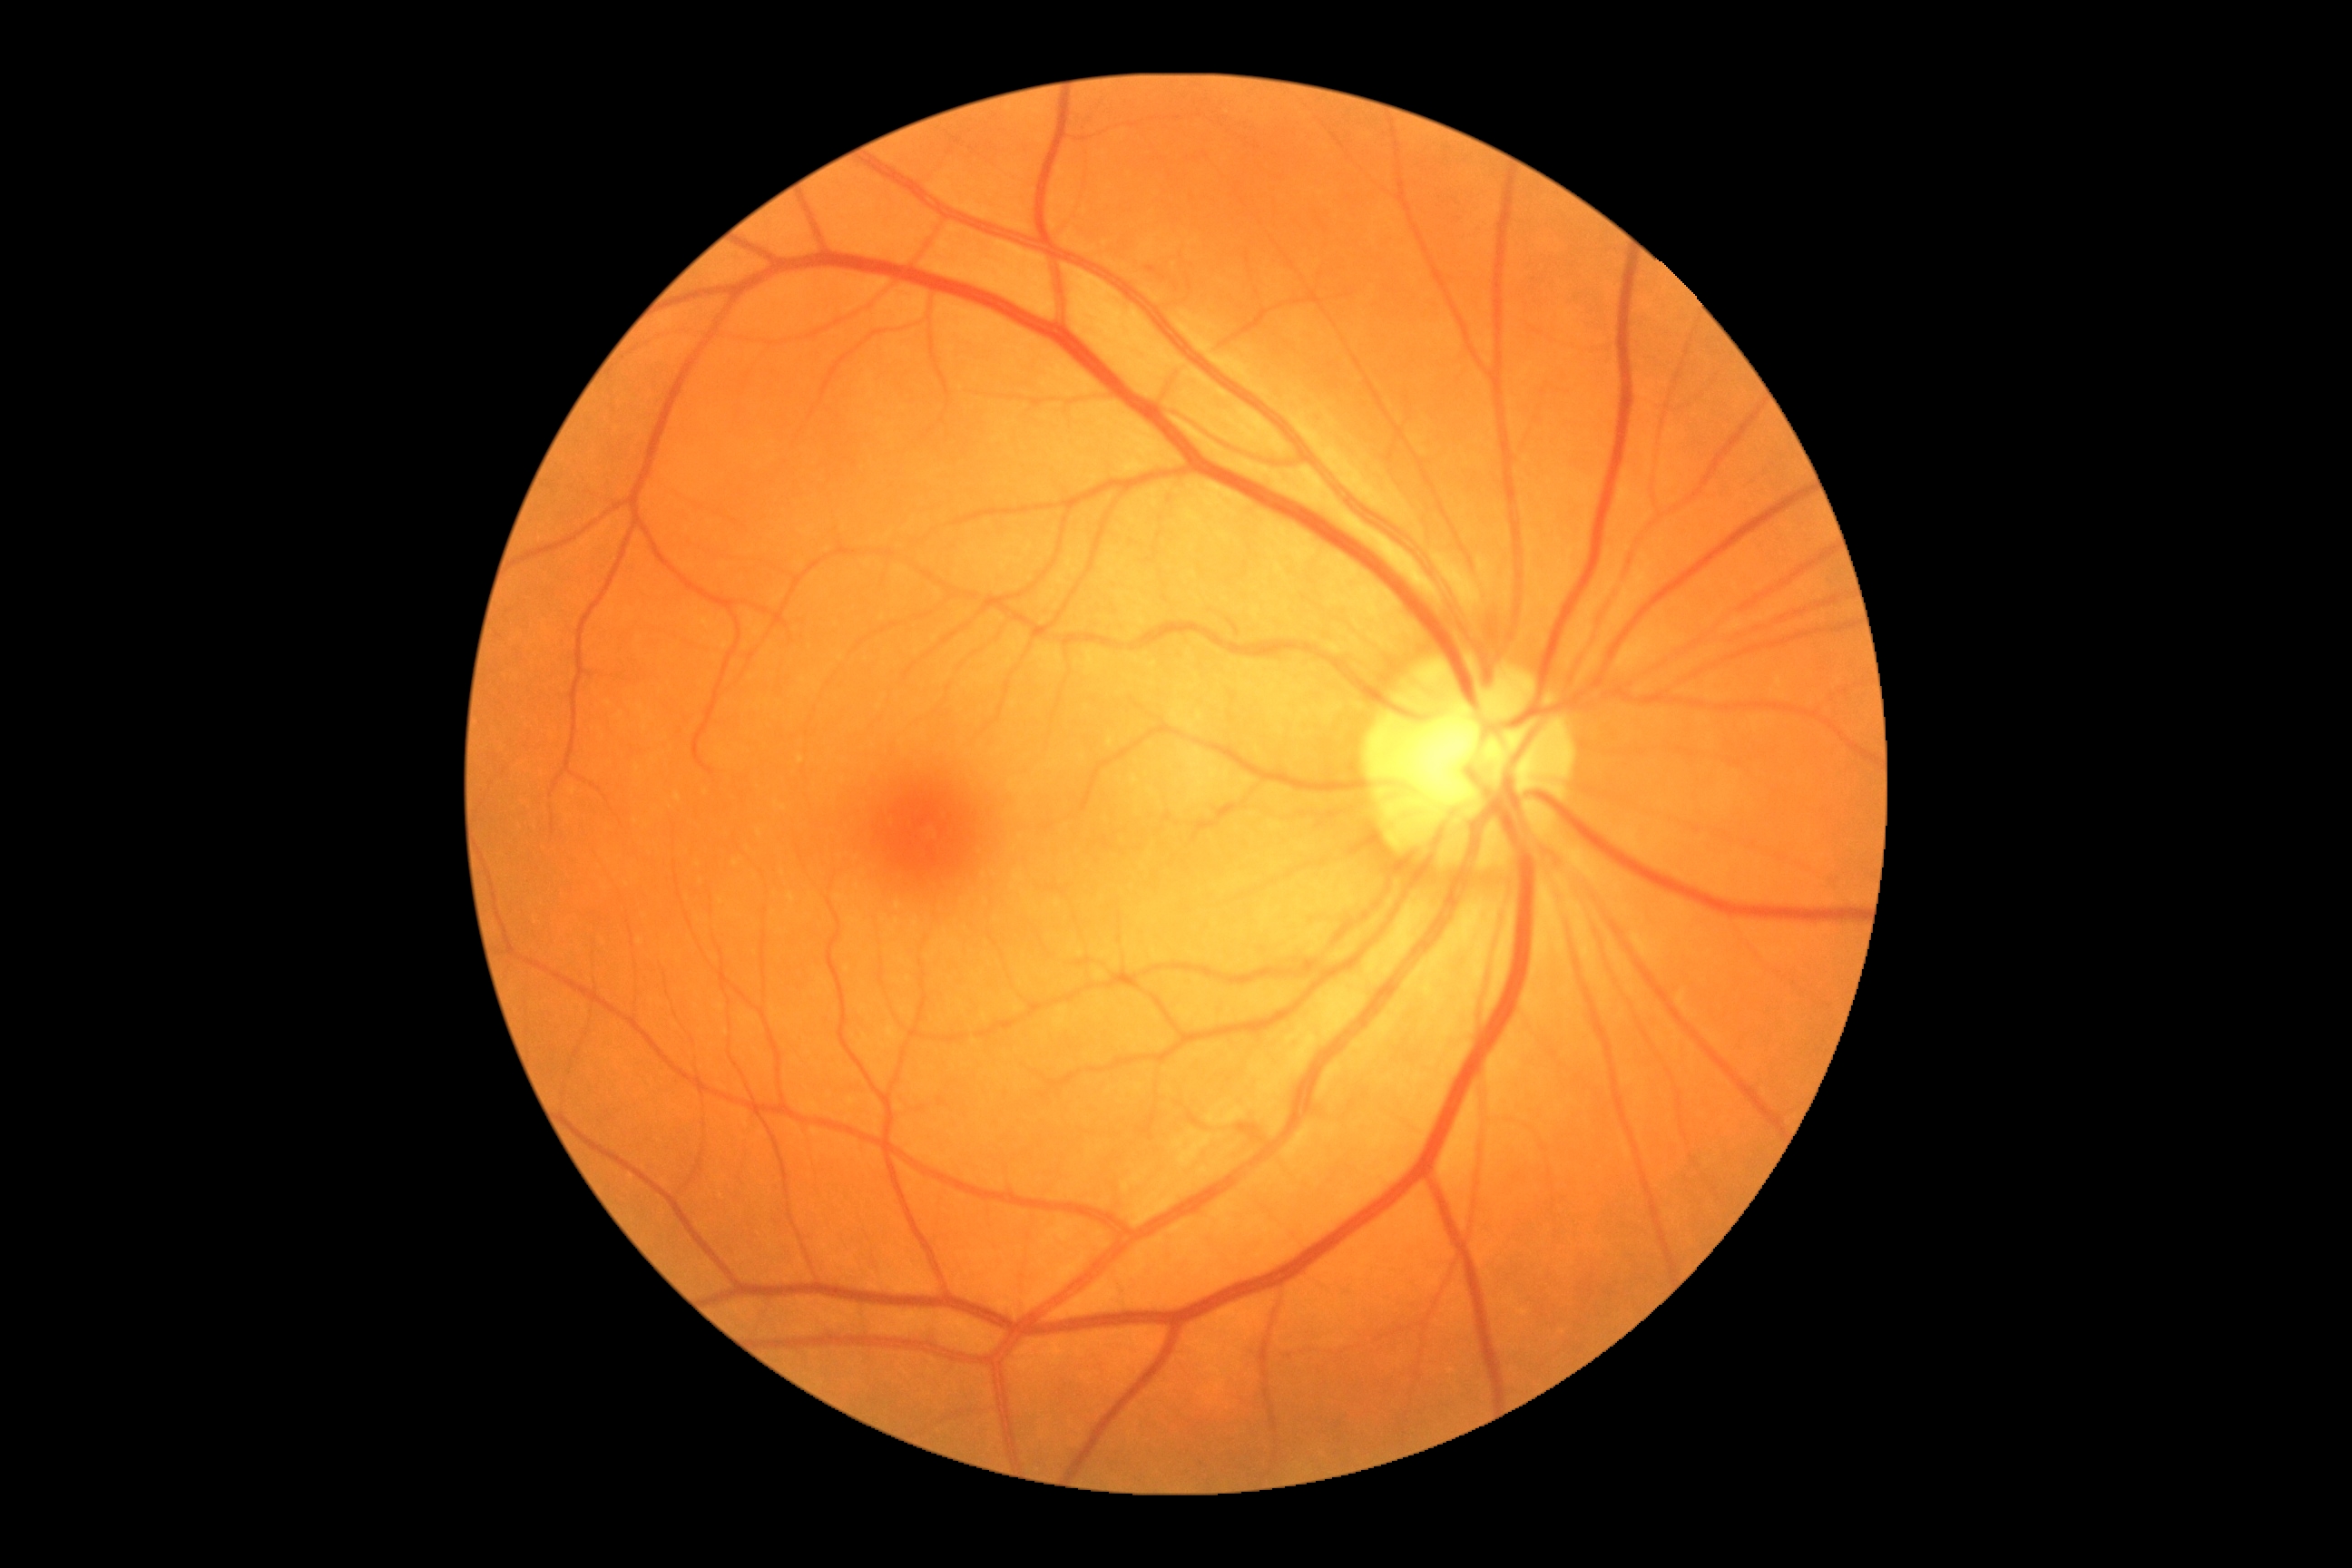
DR: 0/4.